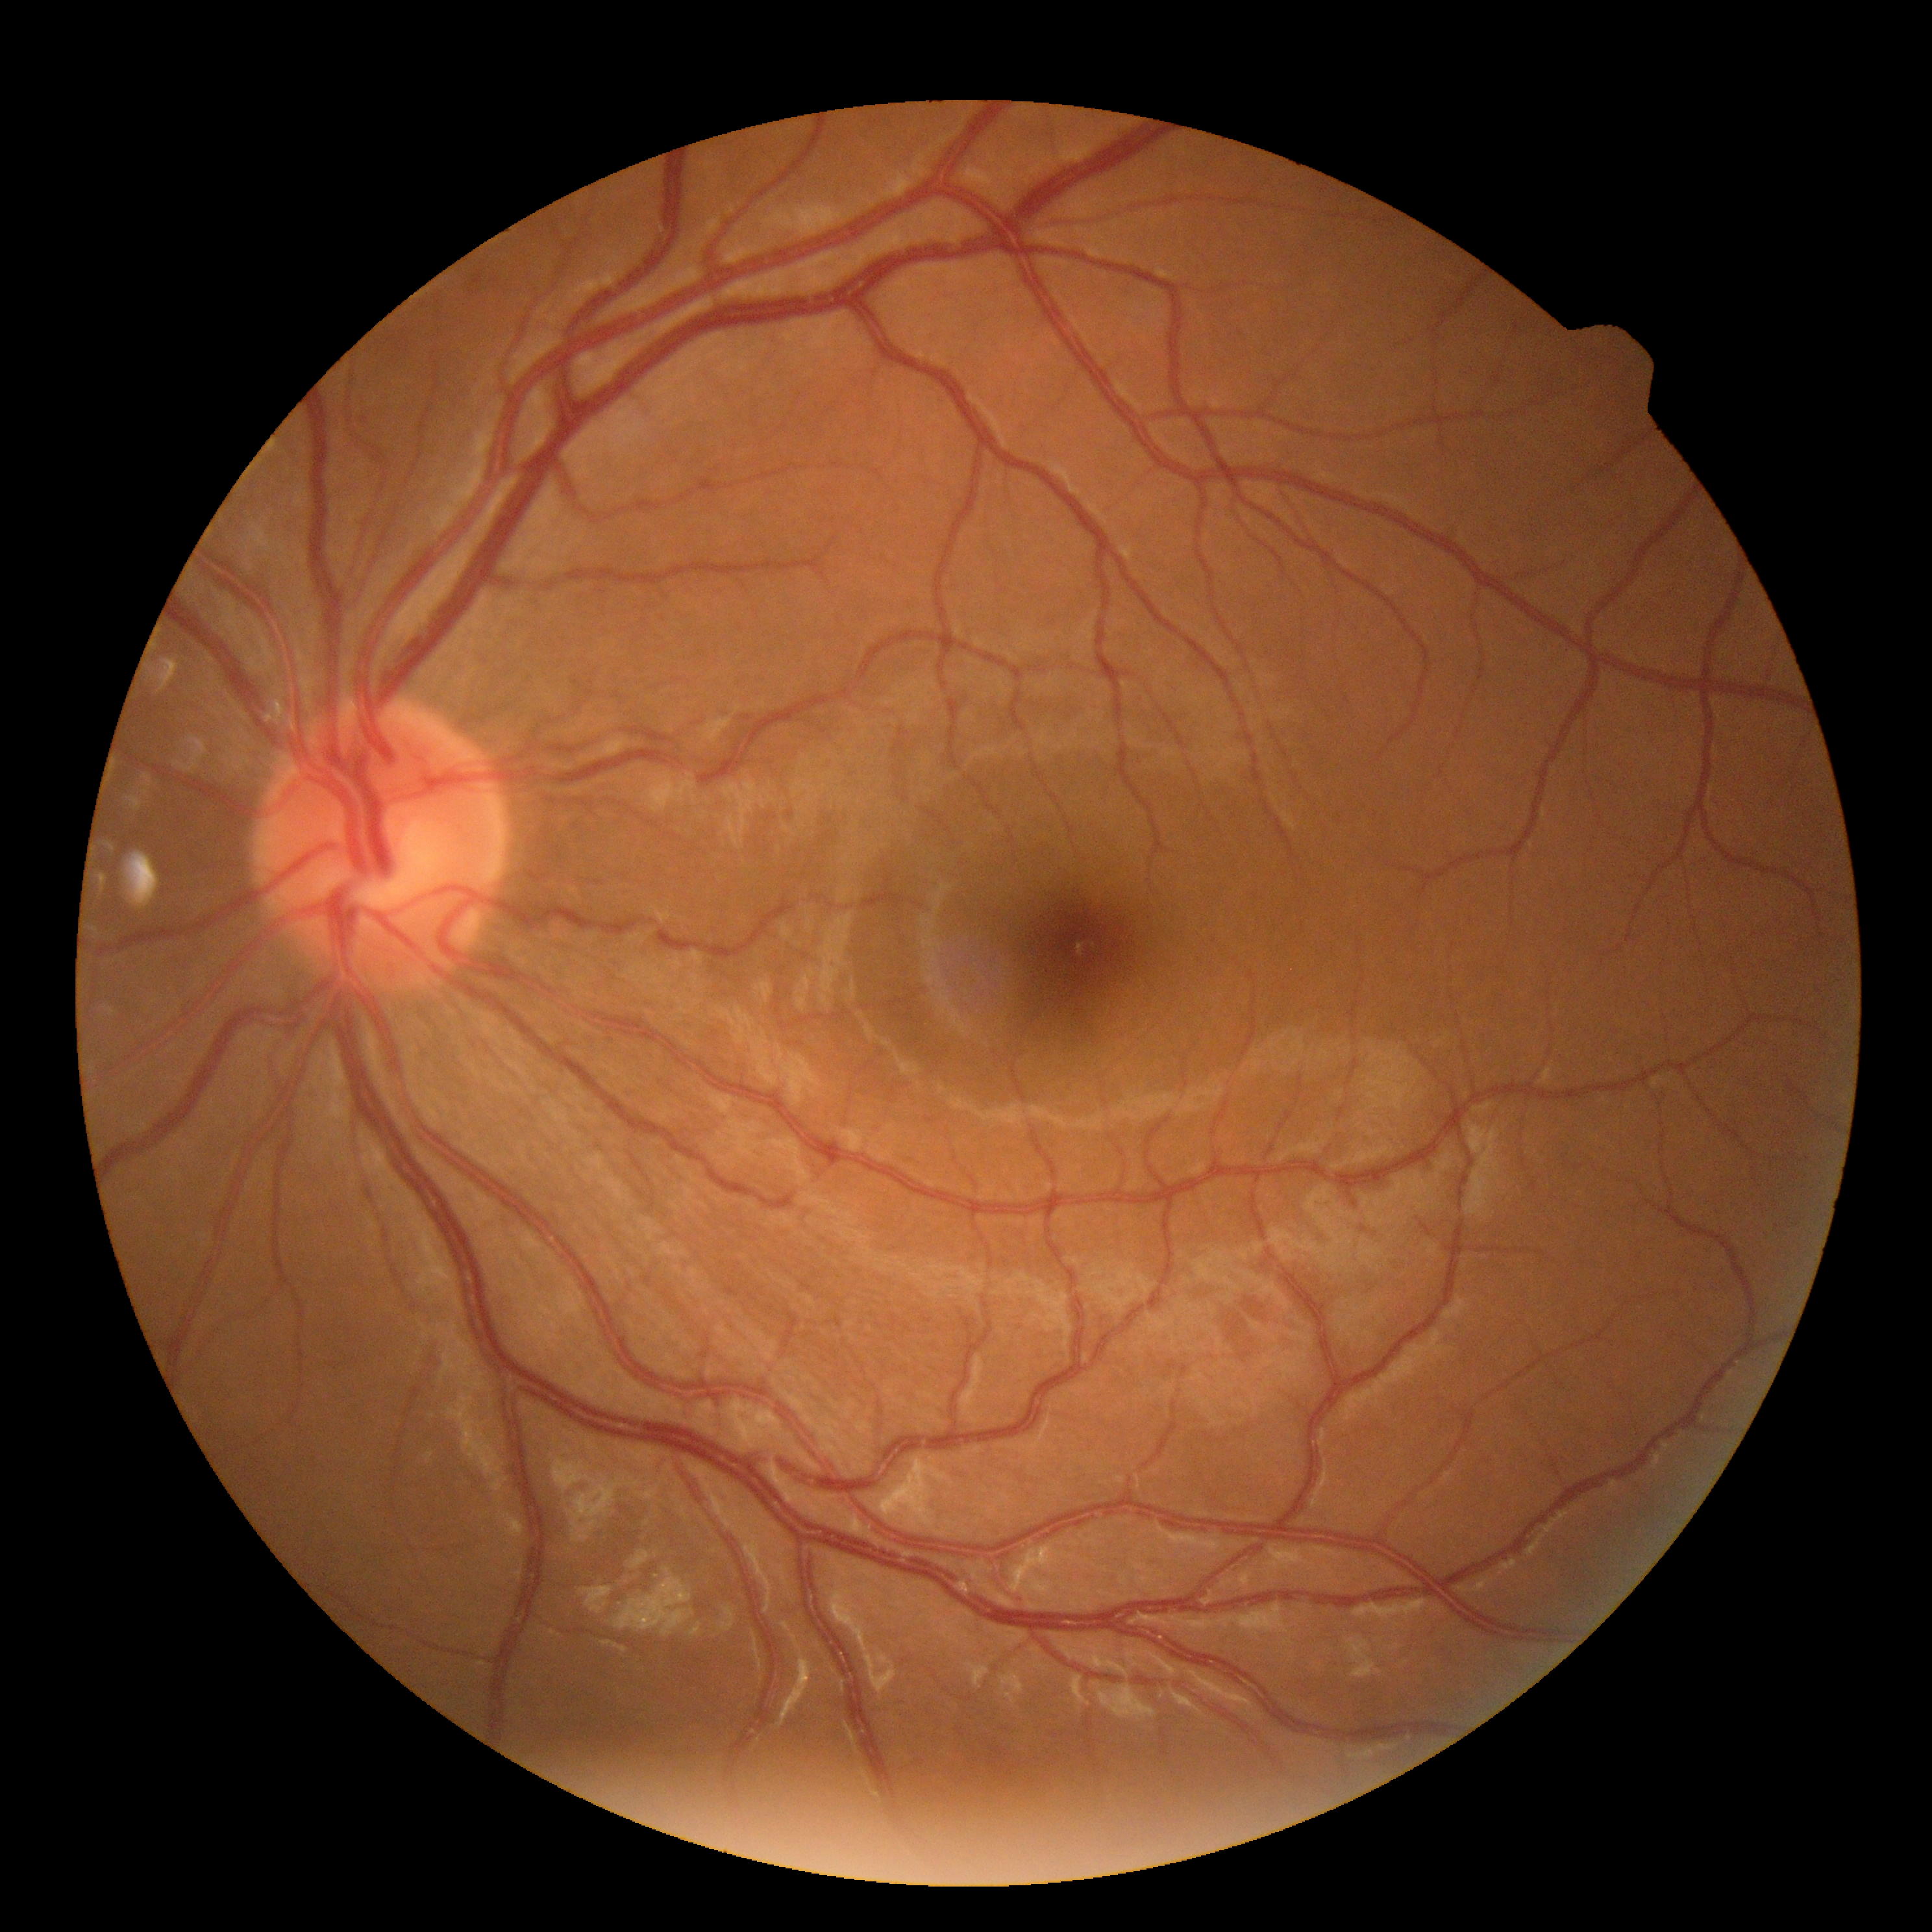 {"dr_impression": "negative for DR", "dr_grade": "0"}